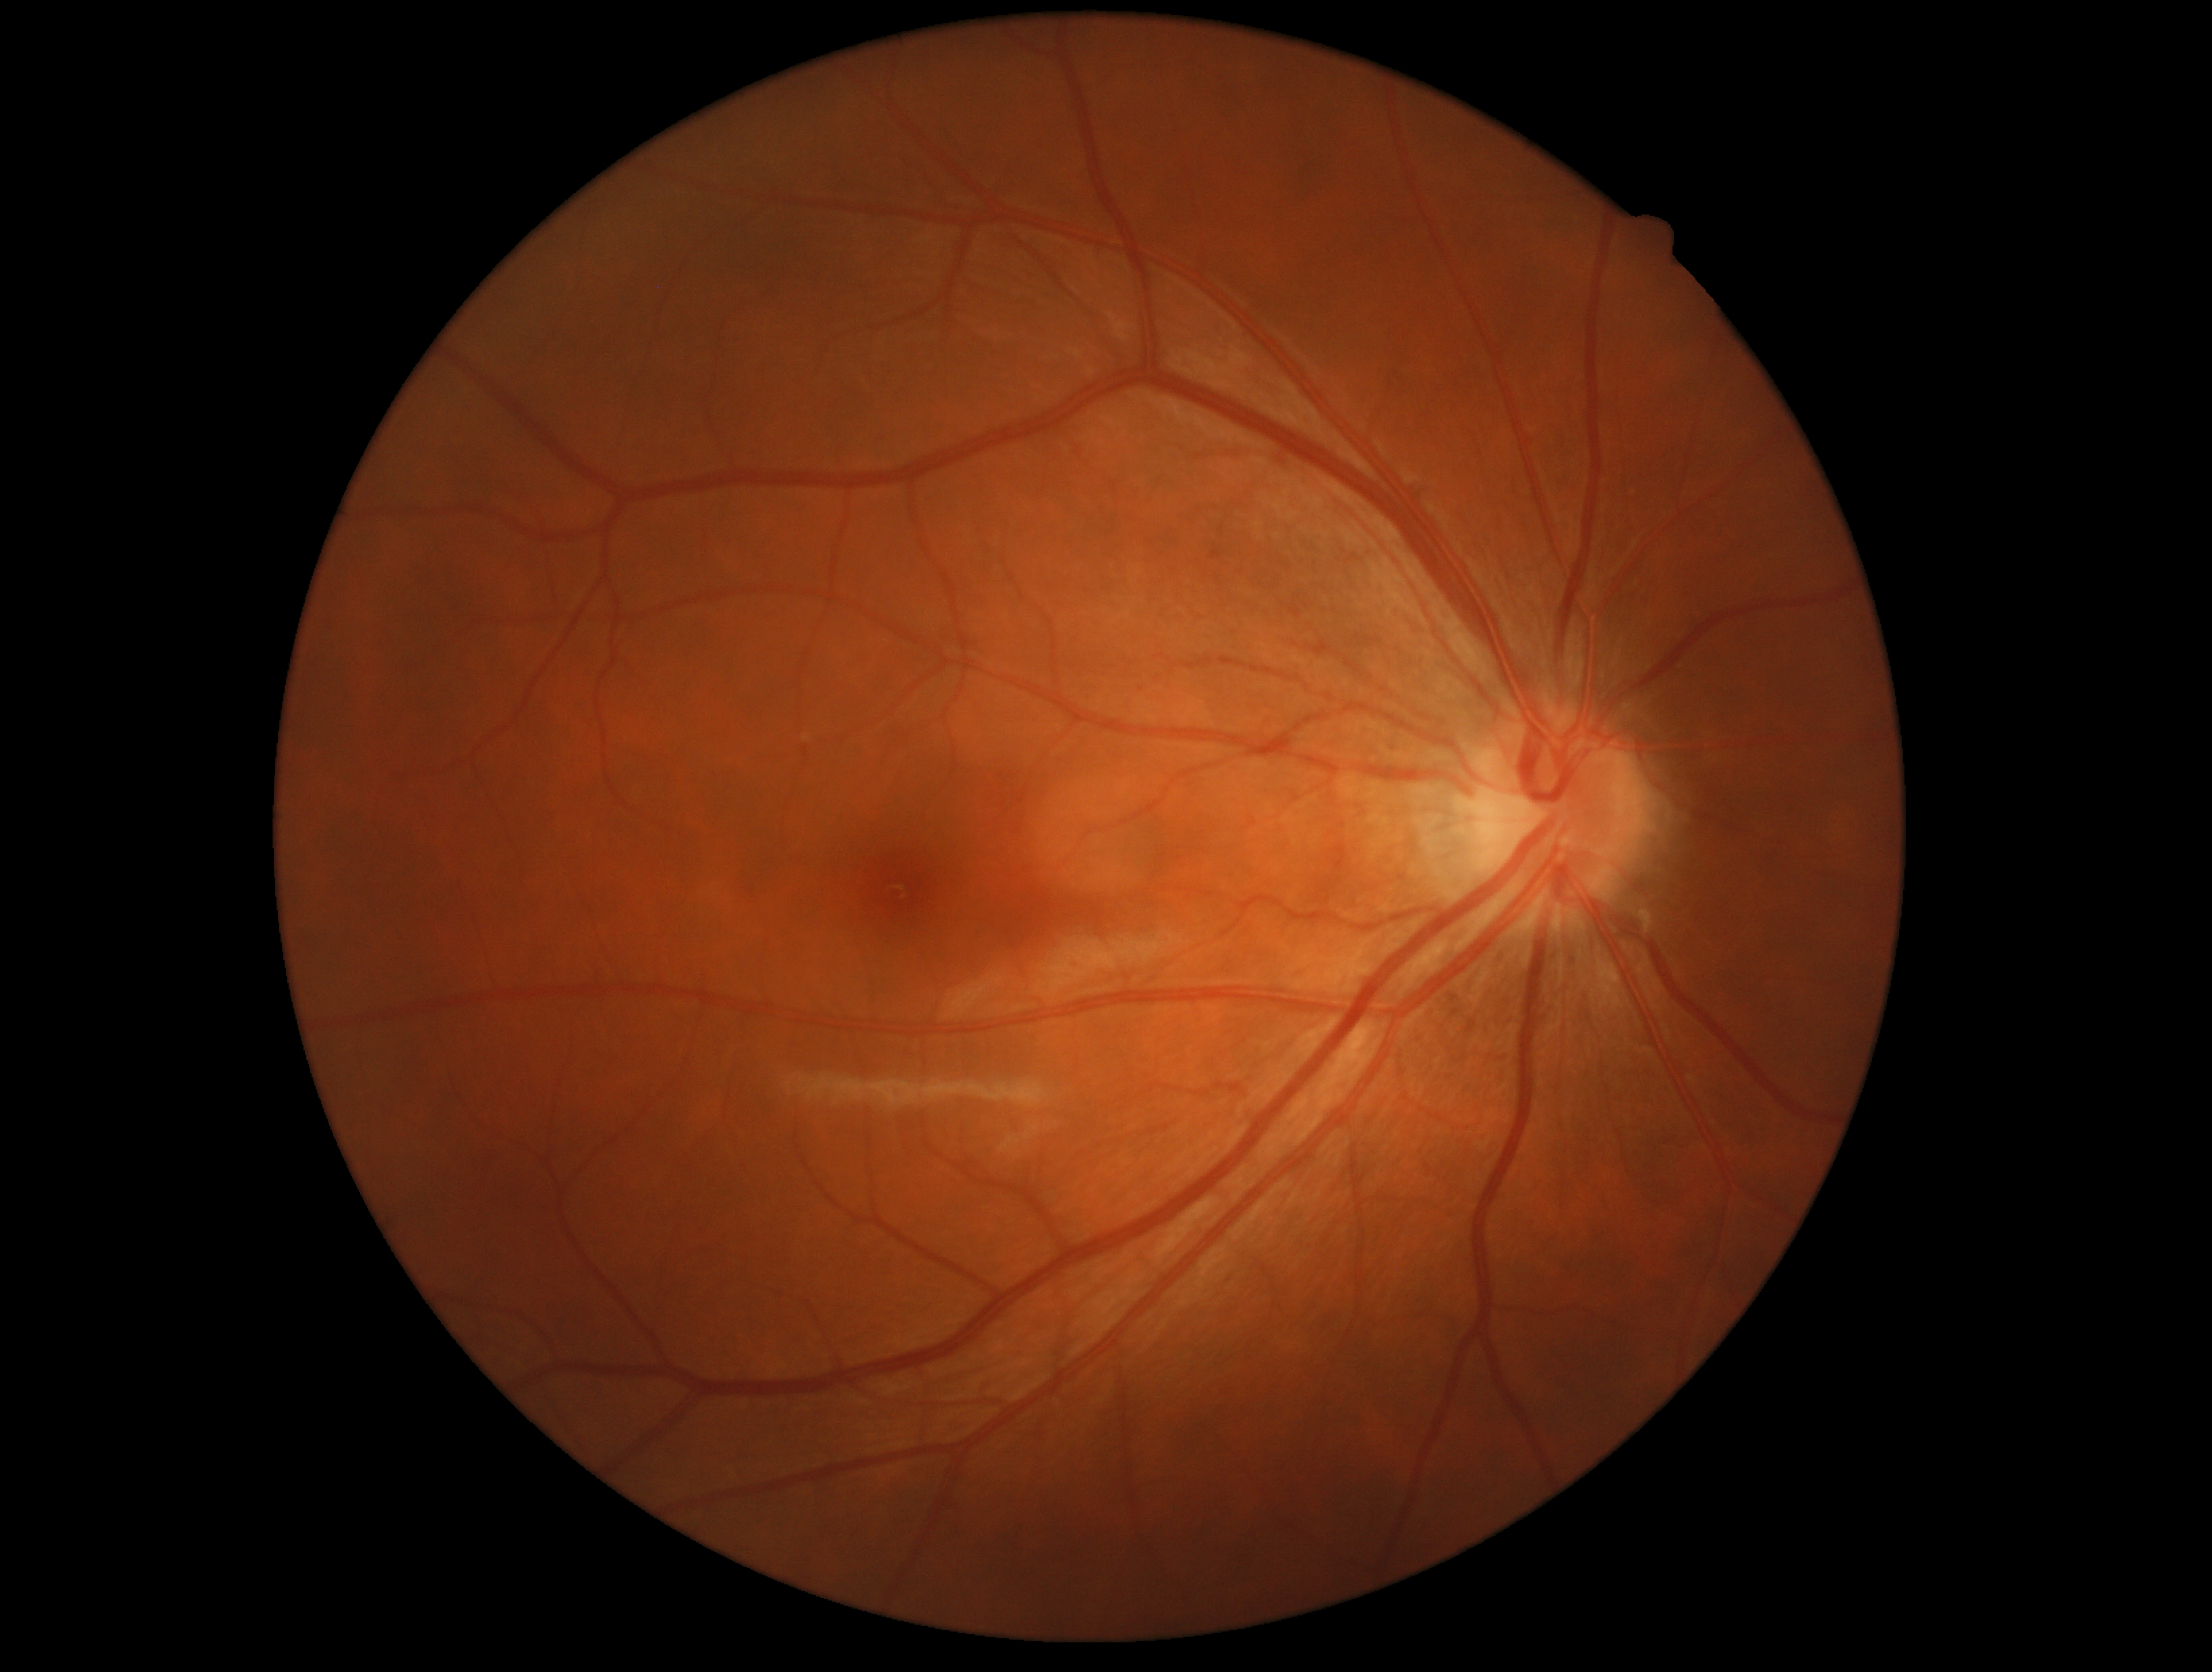 DR is grade 0 (no apparent retinopathy).